848x848px. DR severity per modified Davis staging. CFP: 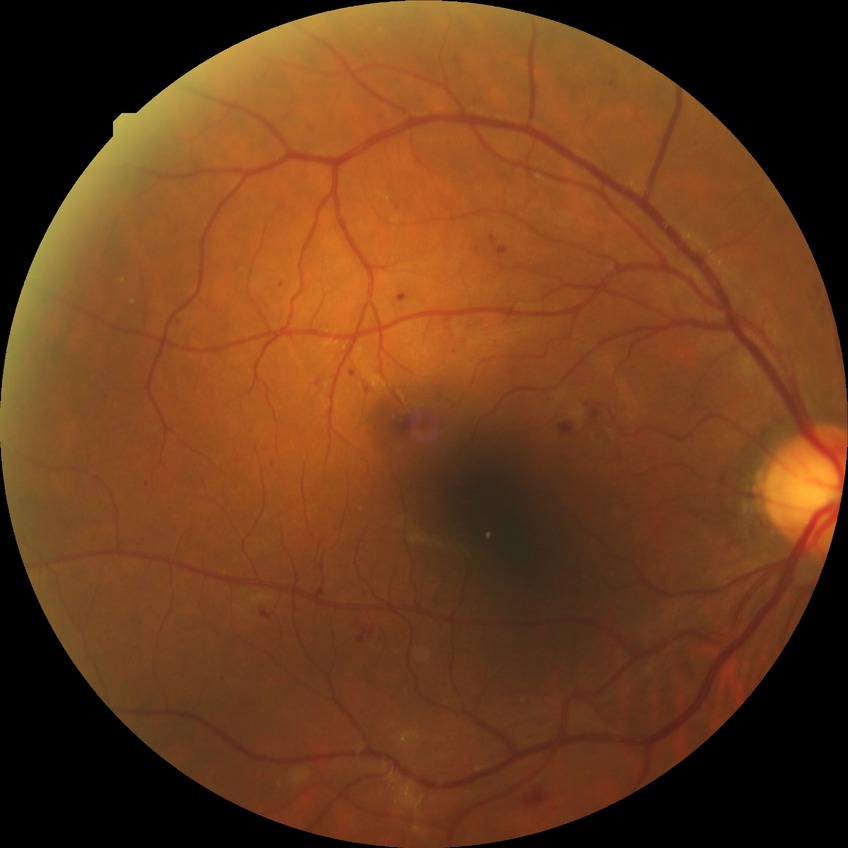
Diabetic retinopathy (DR) is SDR (simple diabetic retinopathy).